Wide-field fundus photograph of an infant; 130° field of view (Clarity RetCam 3); 640x480
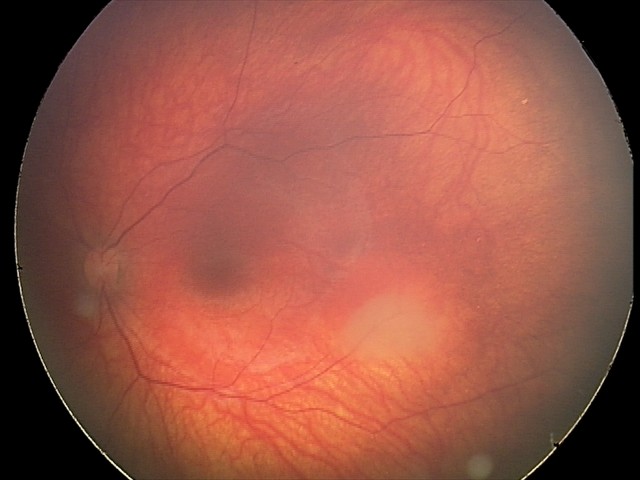 Screening series with retinal astrocytic hamartoma.